Nonmydriatic; posterior pole photograph:
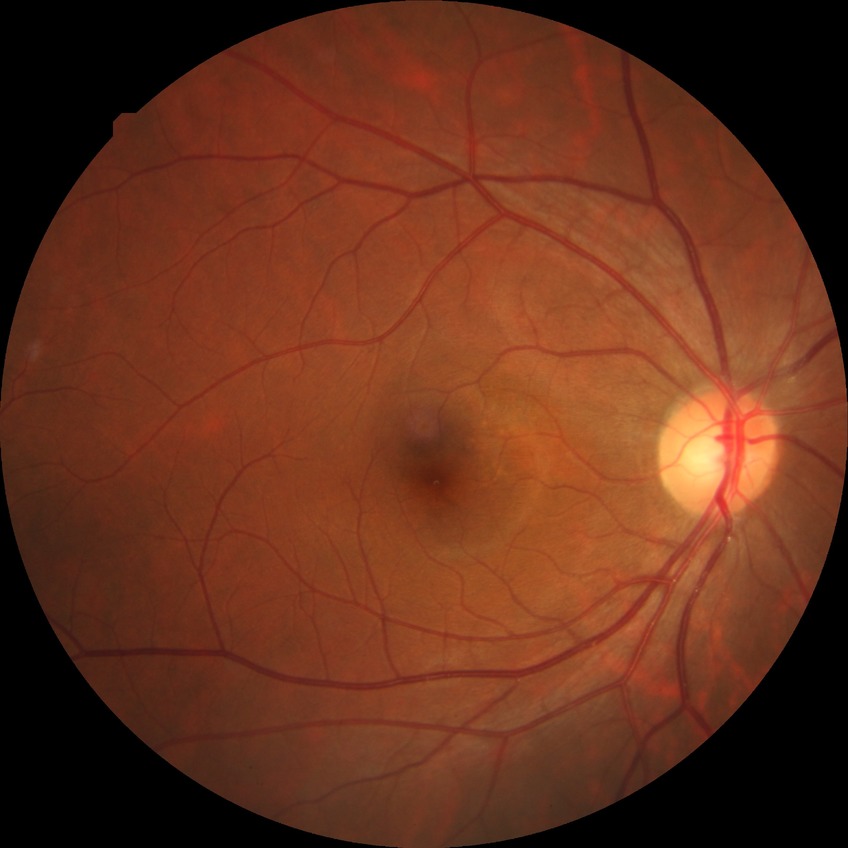
  davis_grade: no diabetic retinopathy